45 degree fundus photograph, nonmydriatic fundus photograph: 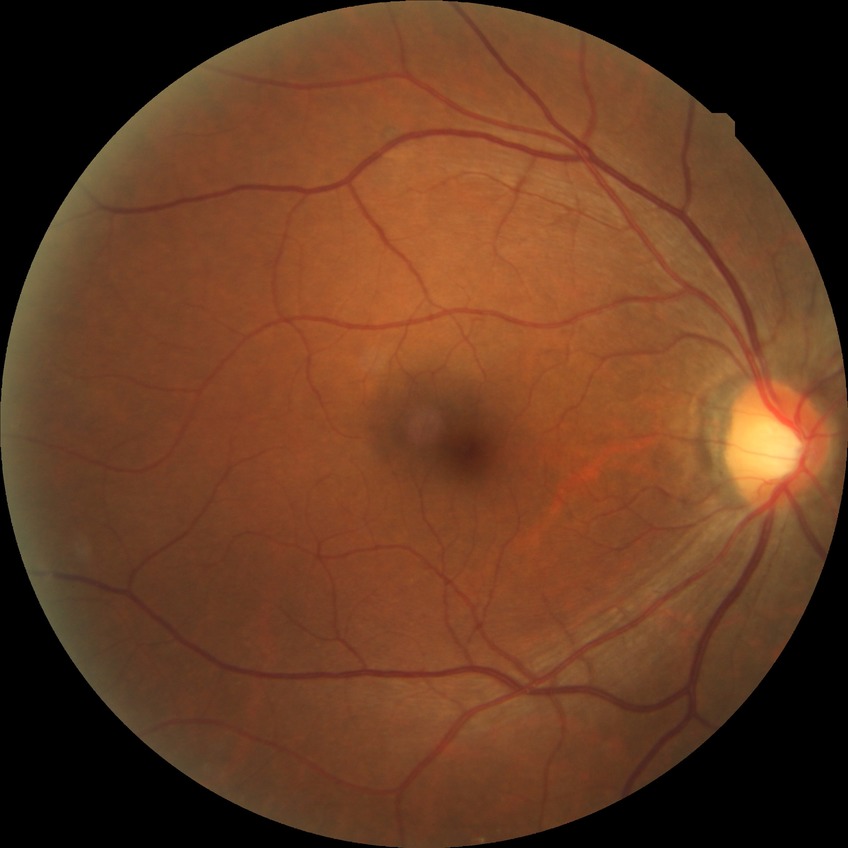

Diabetic retinopathy stage is no diabetic retinopathy.